Image size 512x512 · retinal fundus photograph:
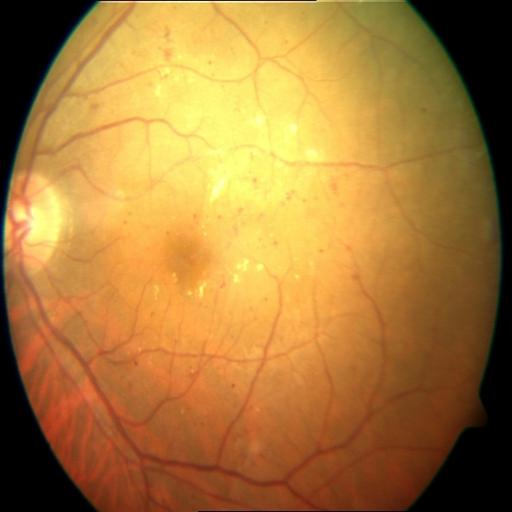 2 findings. Showing hemorrhagic retinopathy (HR) & cystoid macular edema (CME).